Remidio FOP fundus camera, retinal fundus photograph.
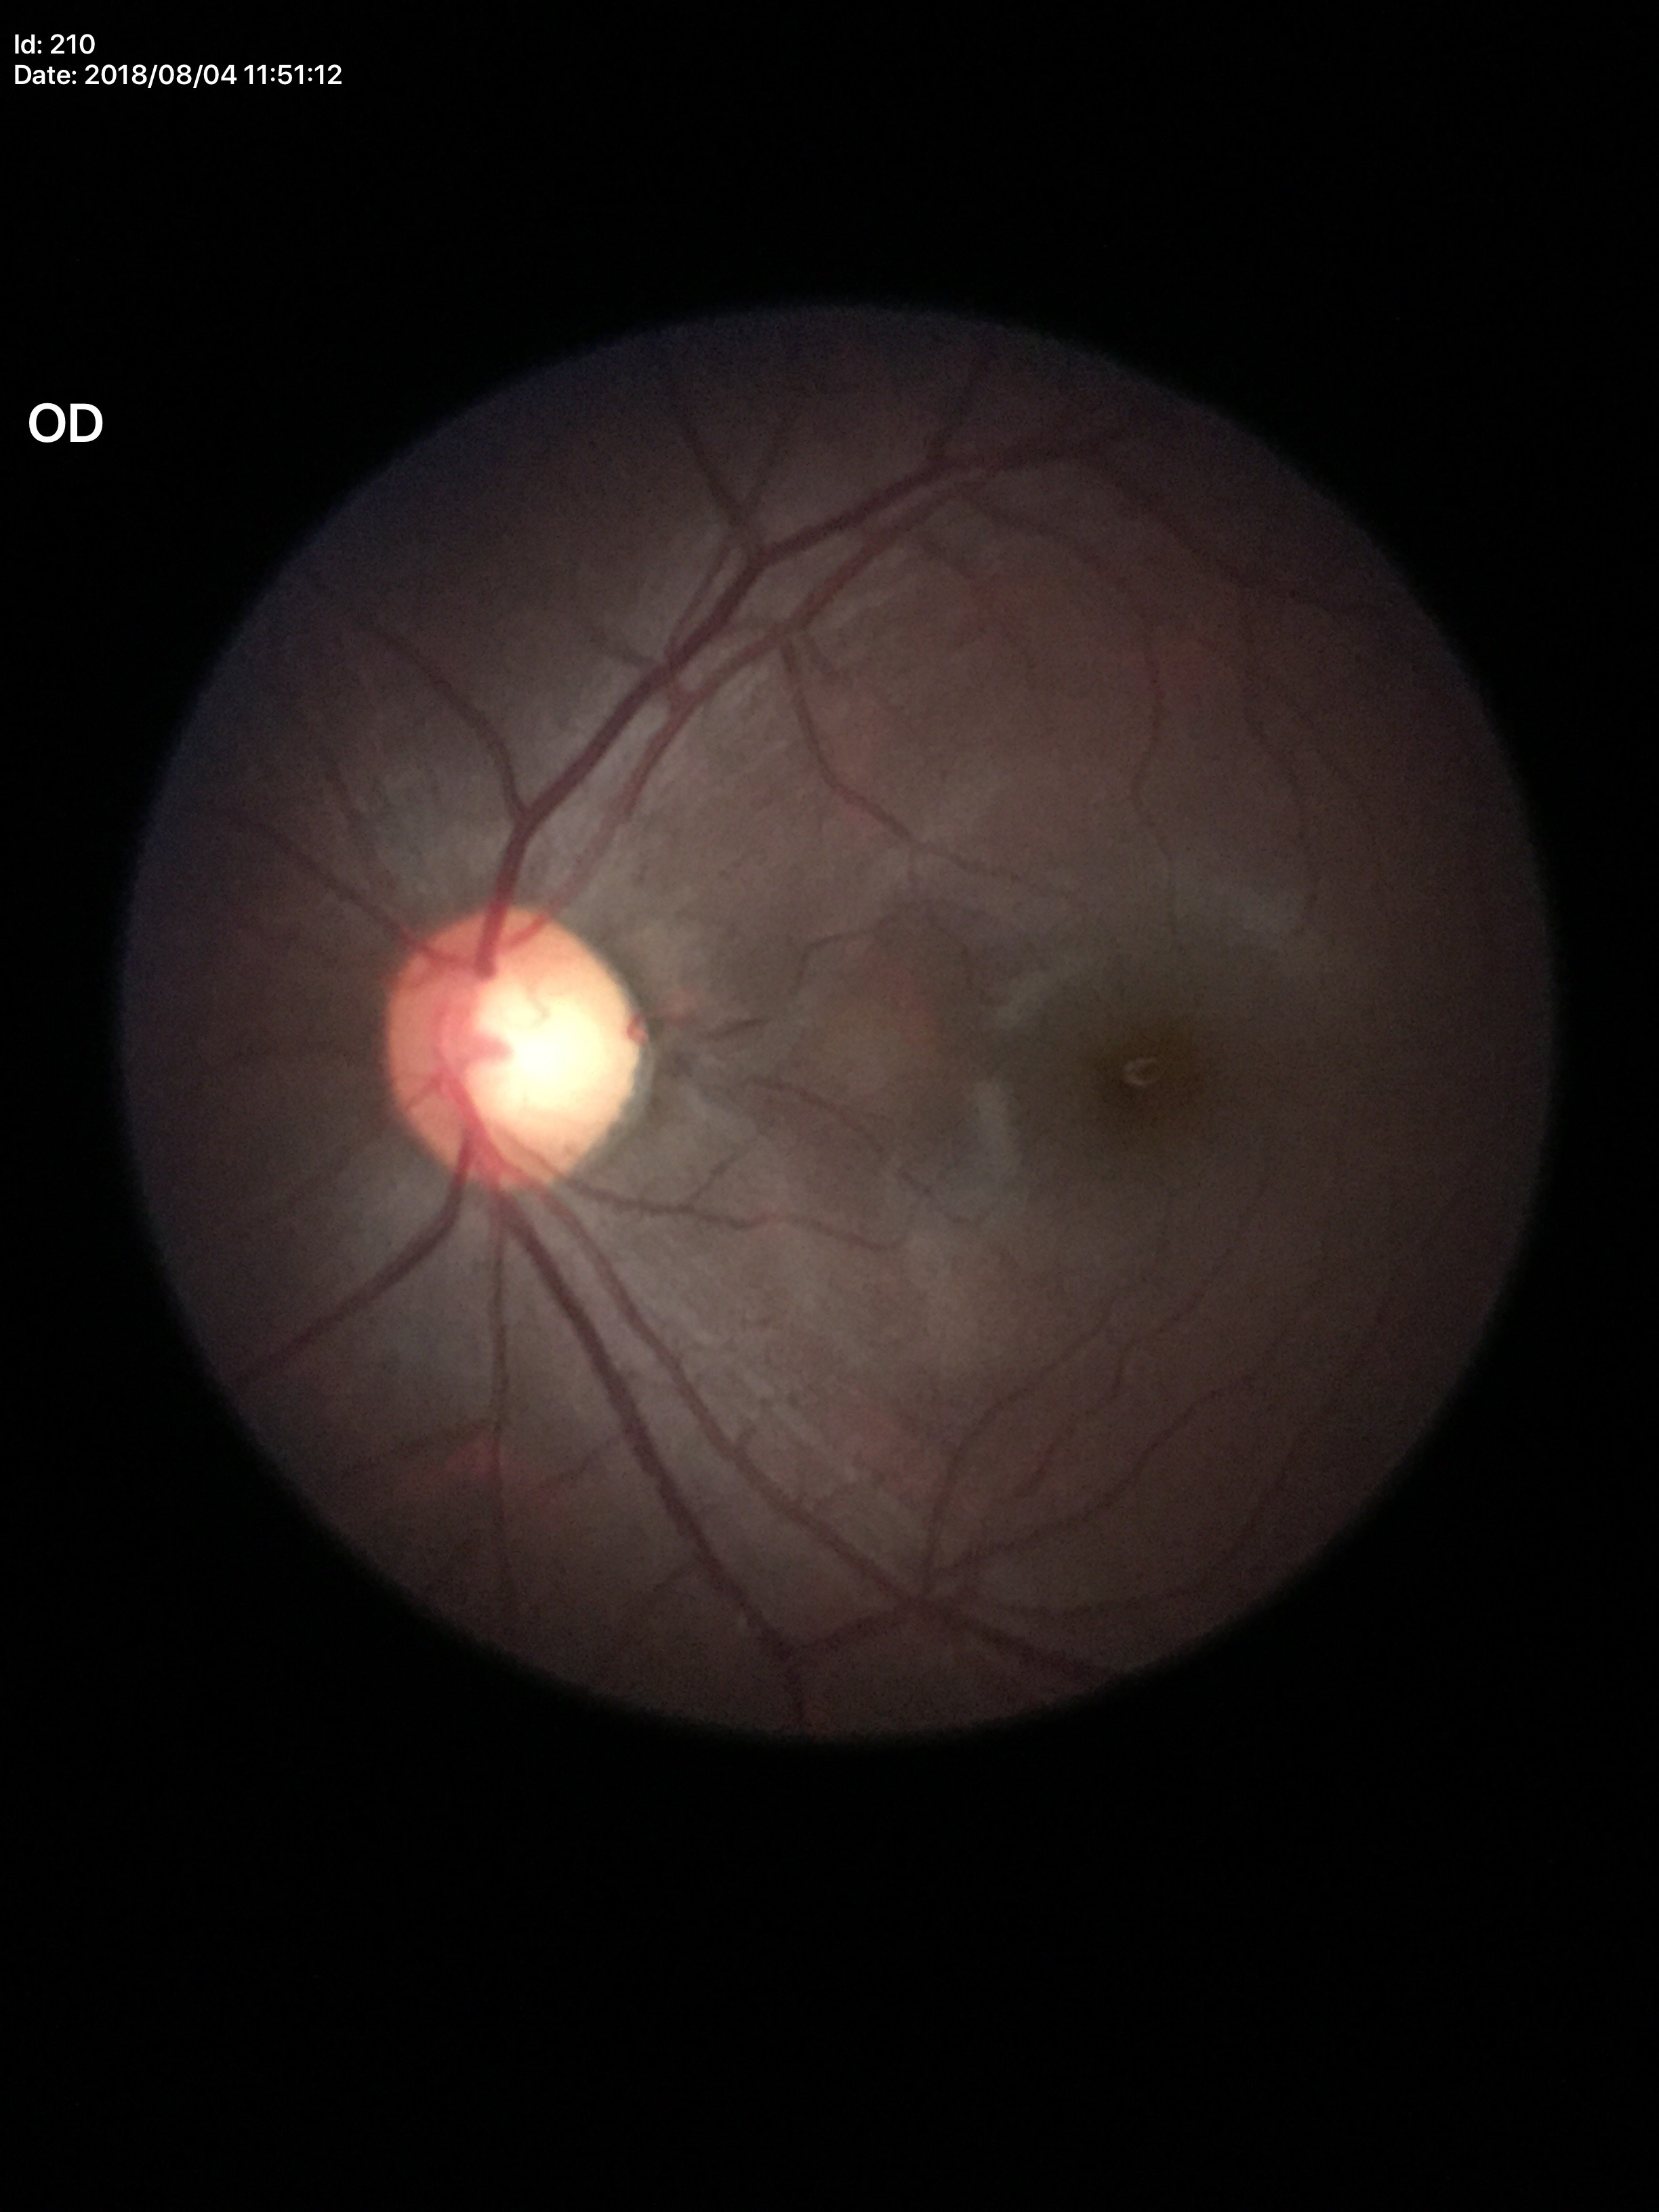

{
  "acdr": "0.42",
  "glaucoma_decision": "suspicious (4 of 5 graders flagged glaucoma suspect)",
  "hcdr": "0.65",
  "vcdr": "0.63"
}